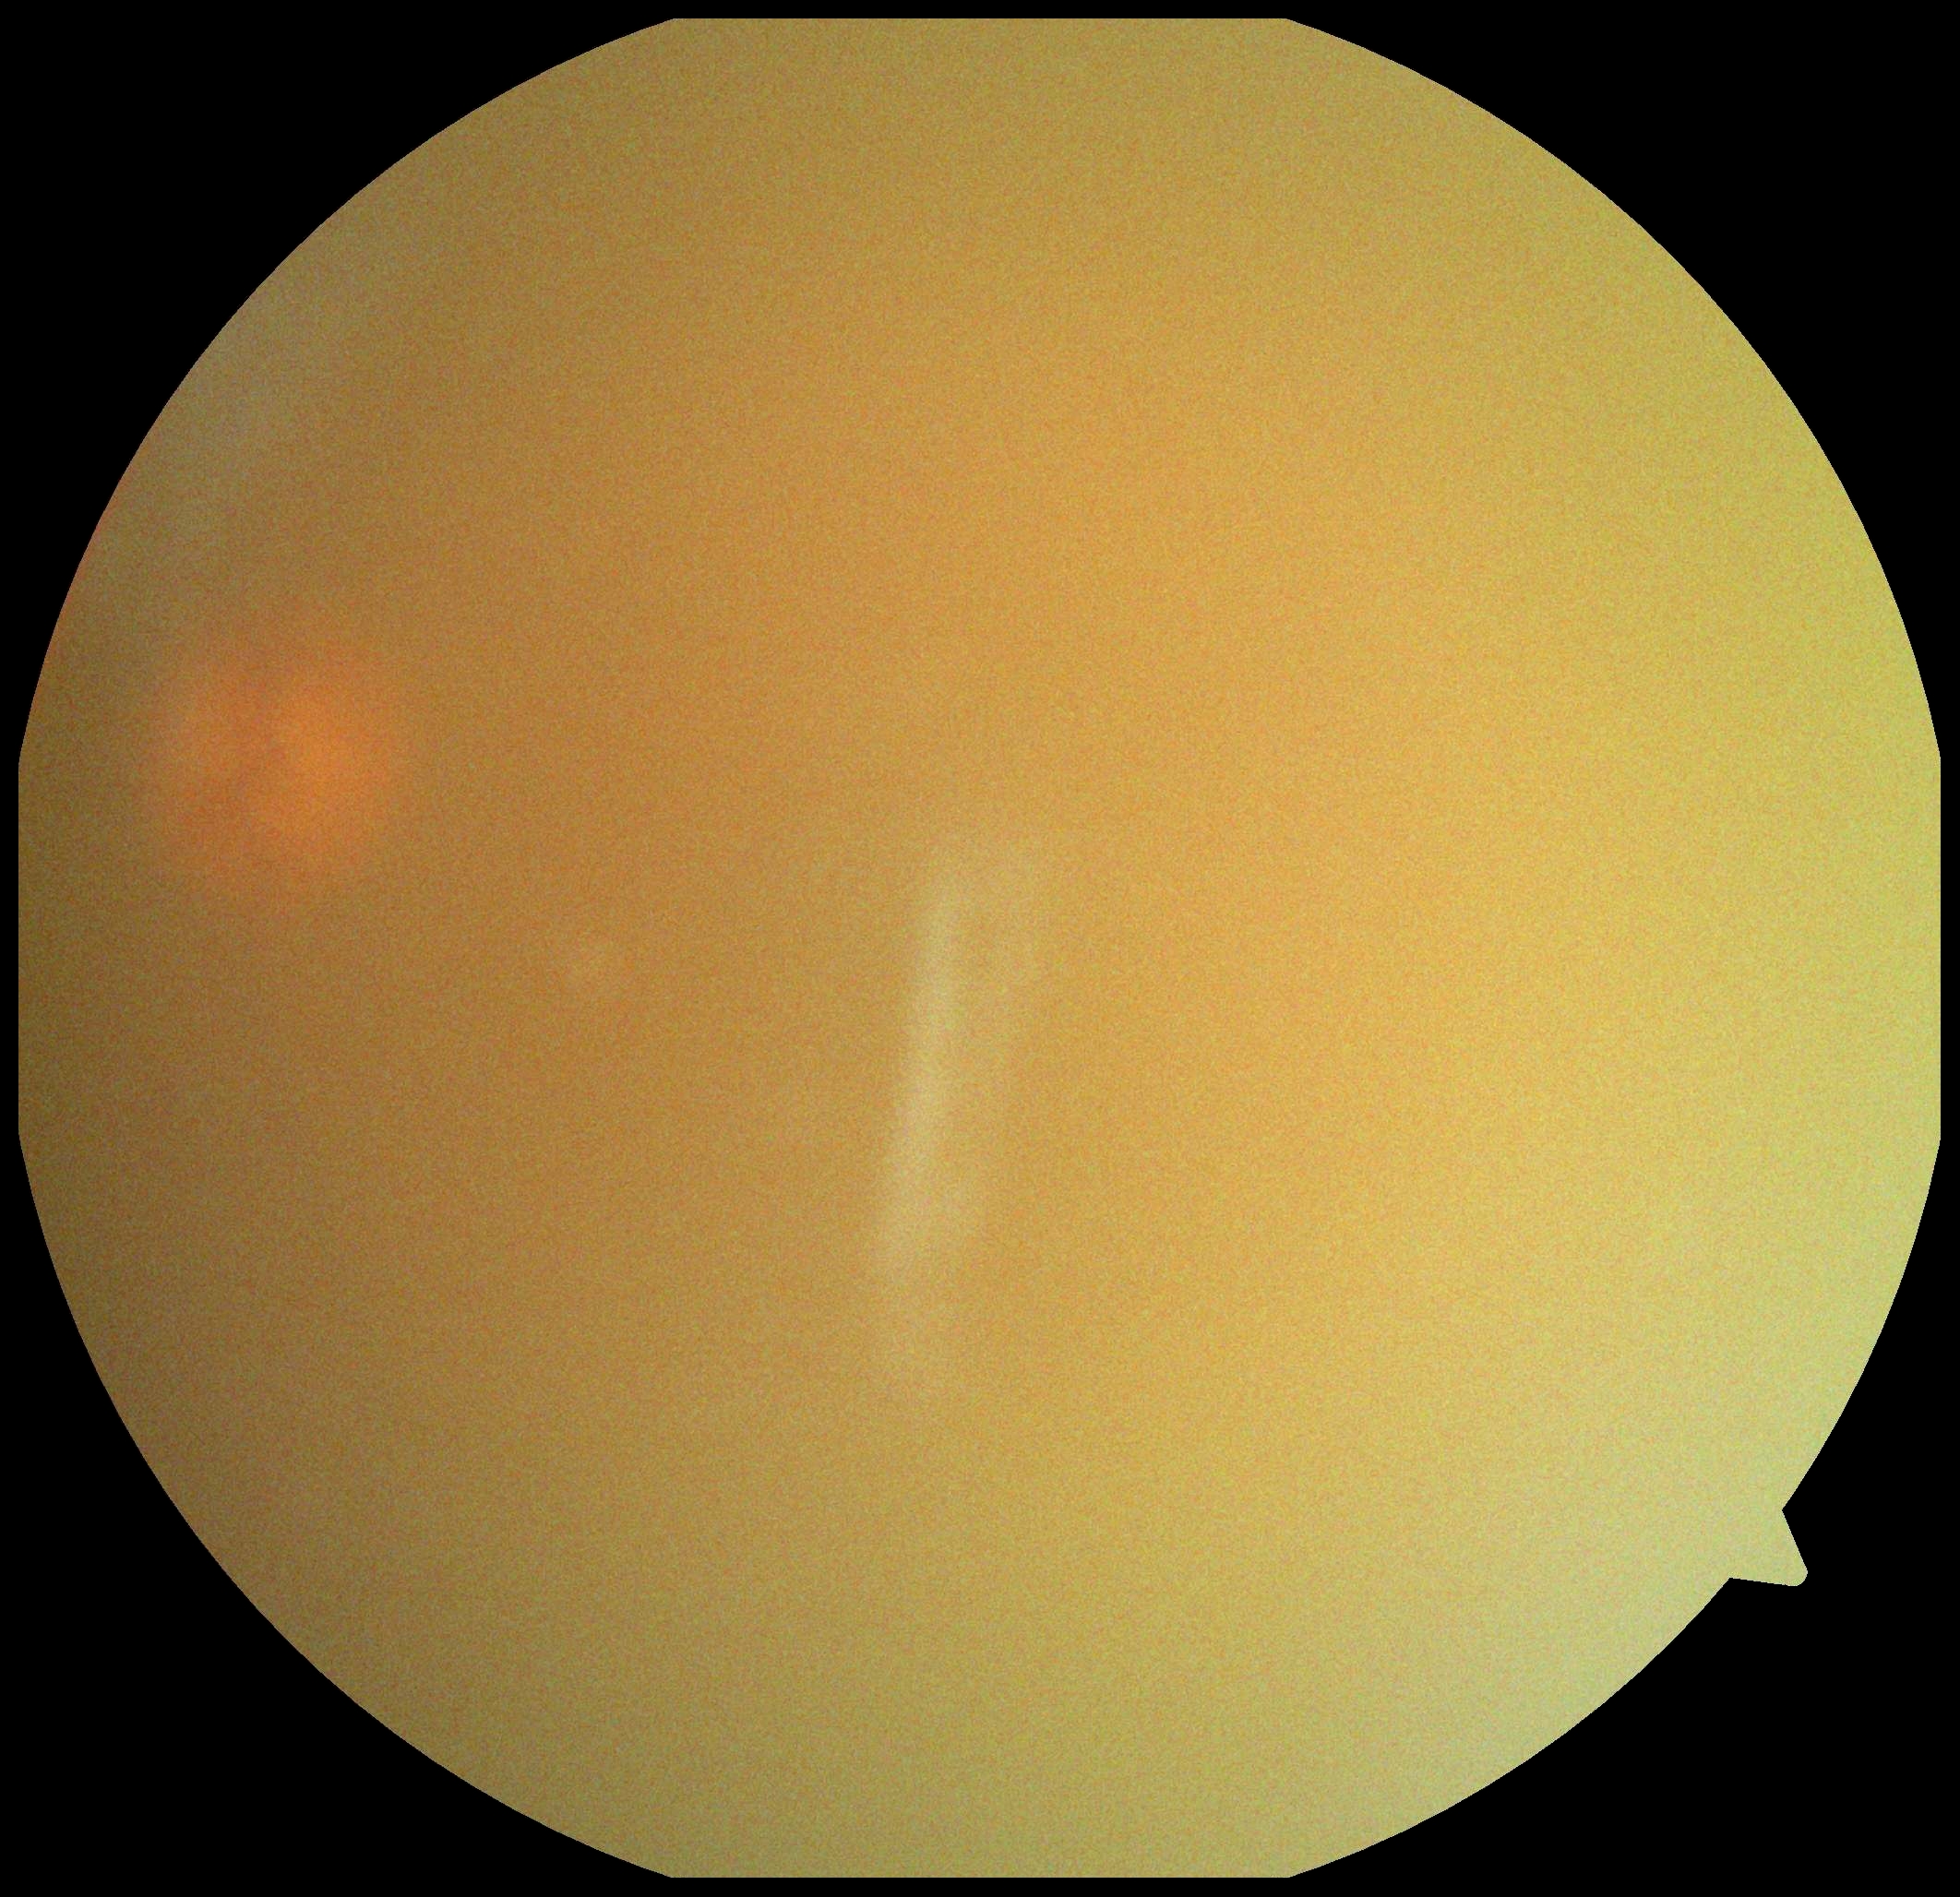   quality: insufficient
  dr_grade: ungradable